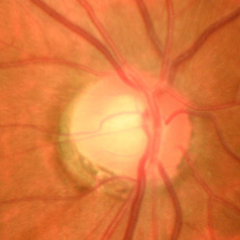
Glaucoma status = early-stage glaucoma.